848 x 848 pixels — 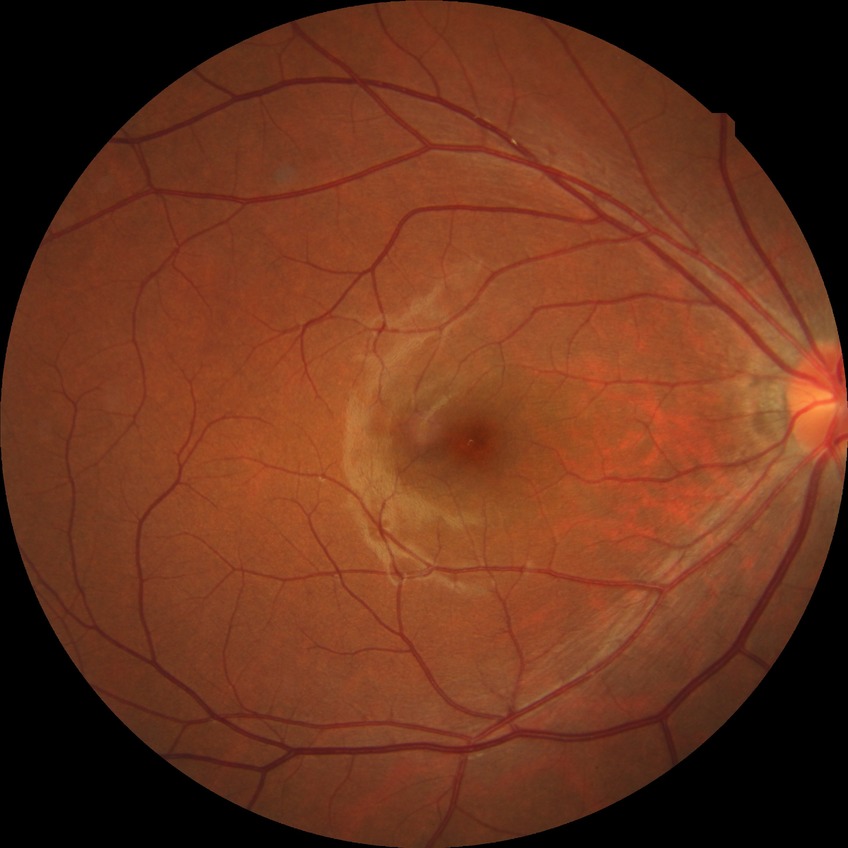

  davis_grade: no diabetic retinopathy